Infant wide-field retinal image. 130° field of view (Natus RetCam Envision). 1440 x 1080 pixels.
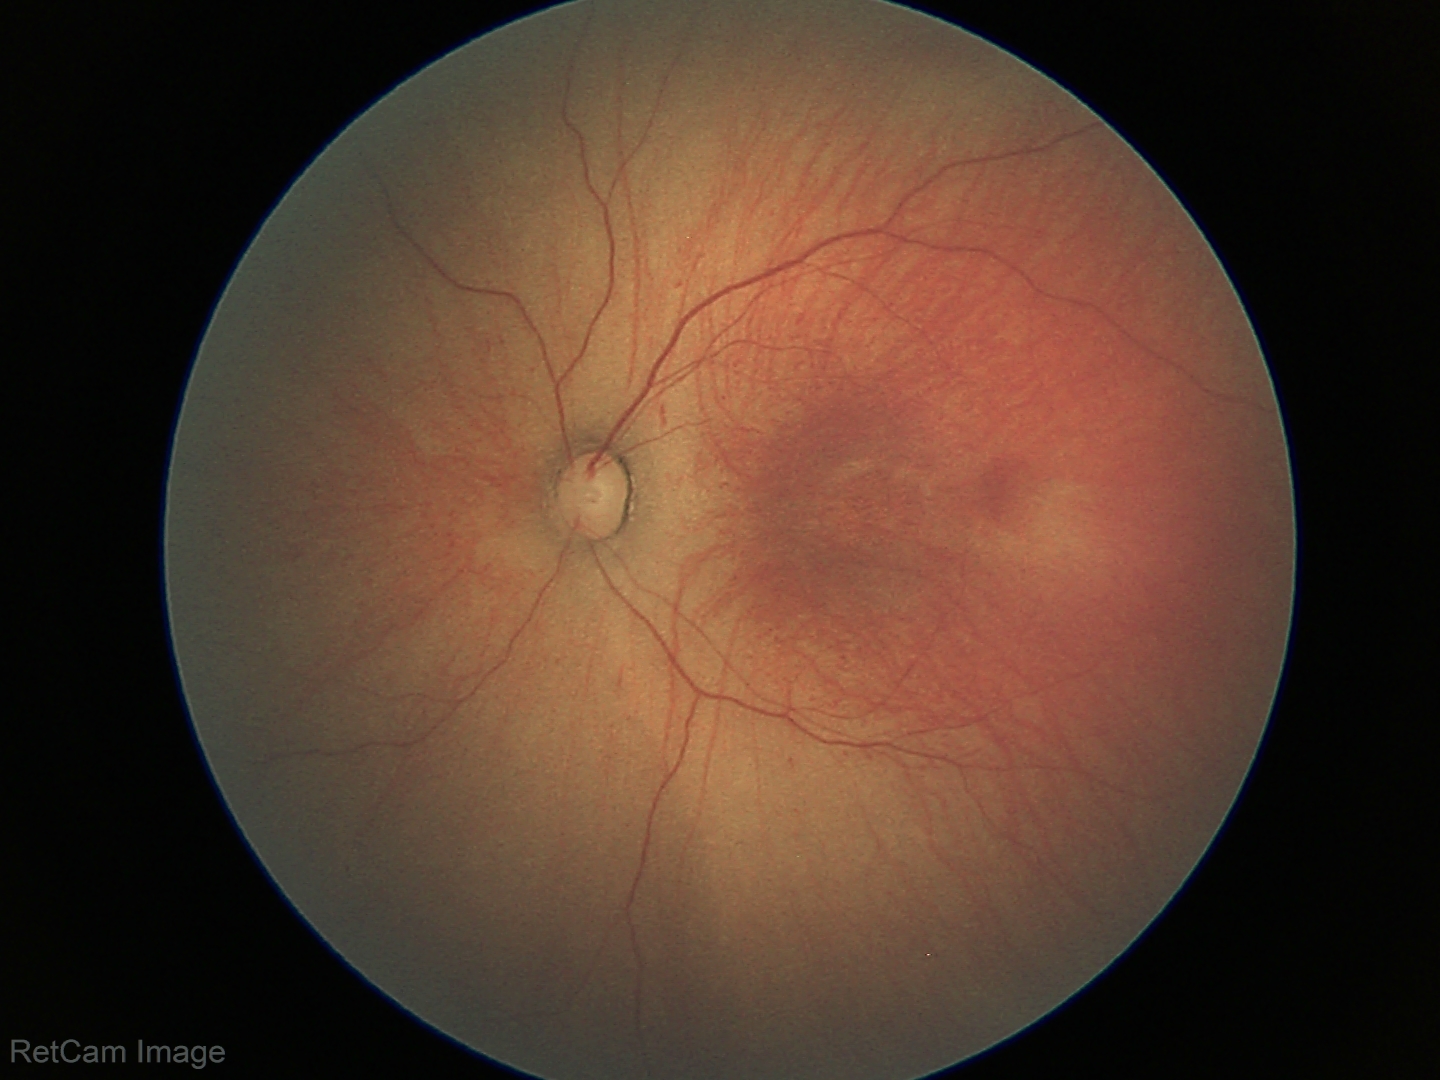
Examination diagnosed as retinopathy of prematurity (ROP) stage 1.
No plus disease.